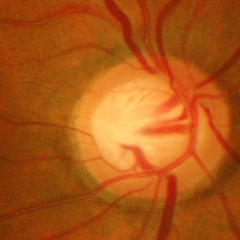

Glaucomatous changes are present. Glaucoma assessment = advanced-stage glaucoma.